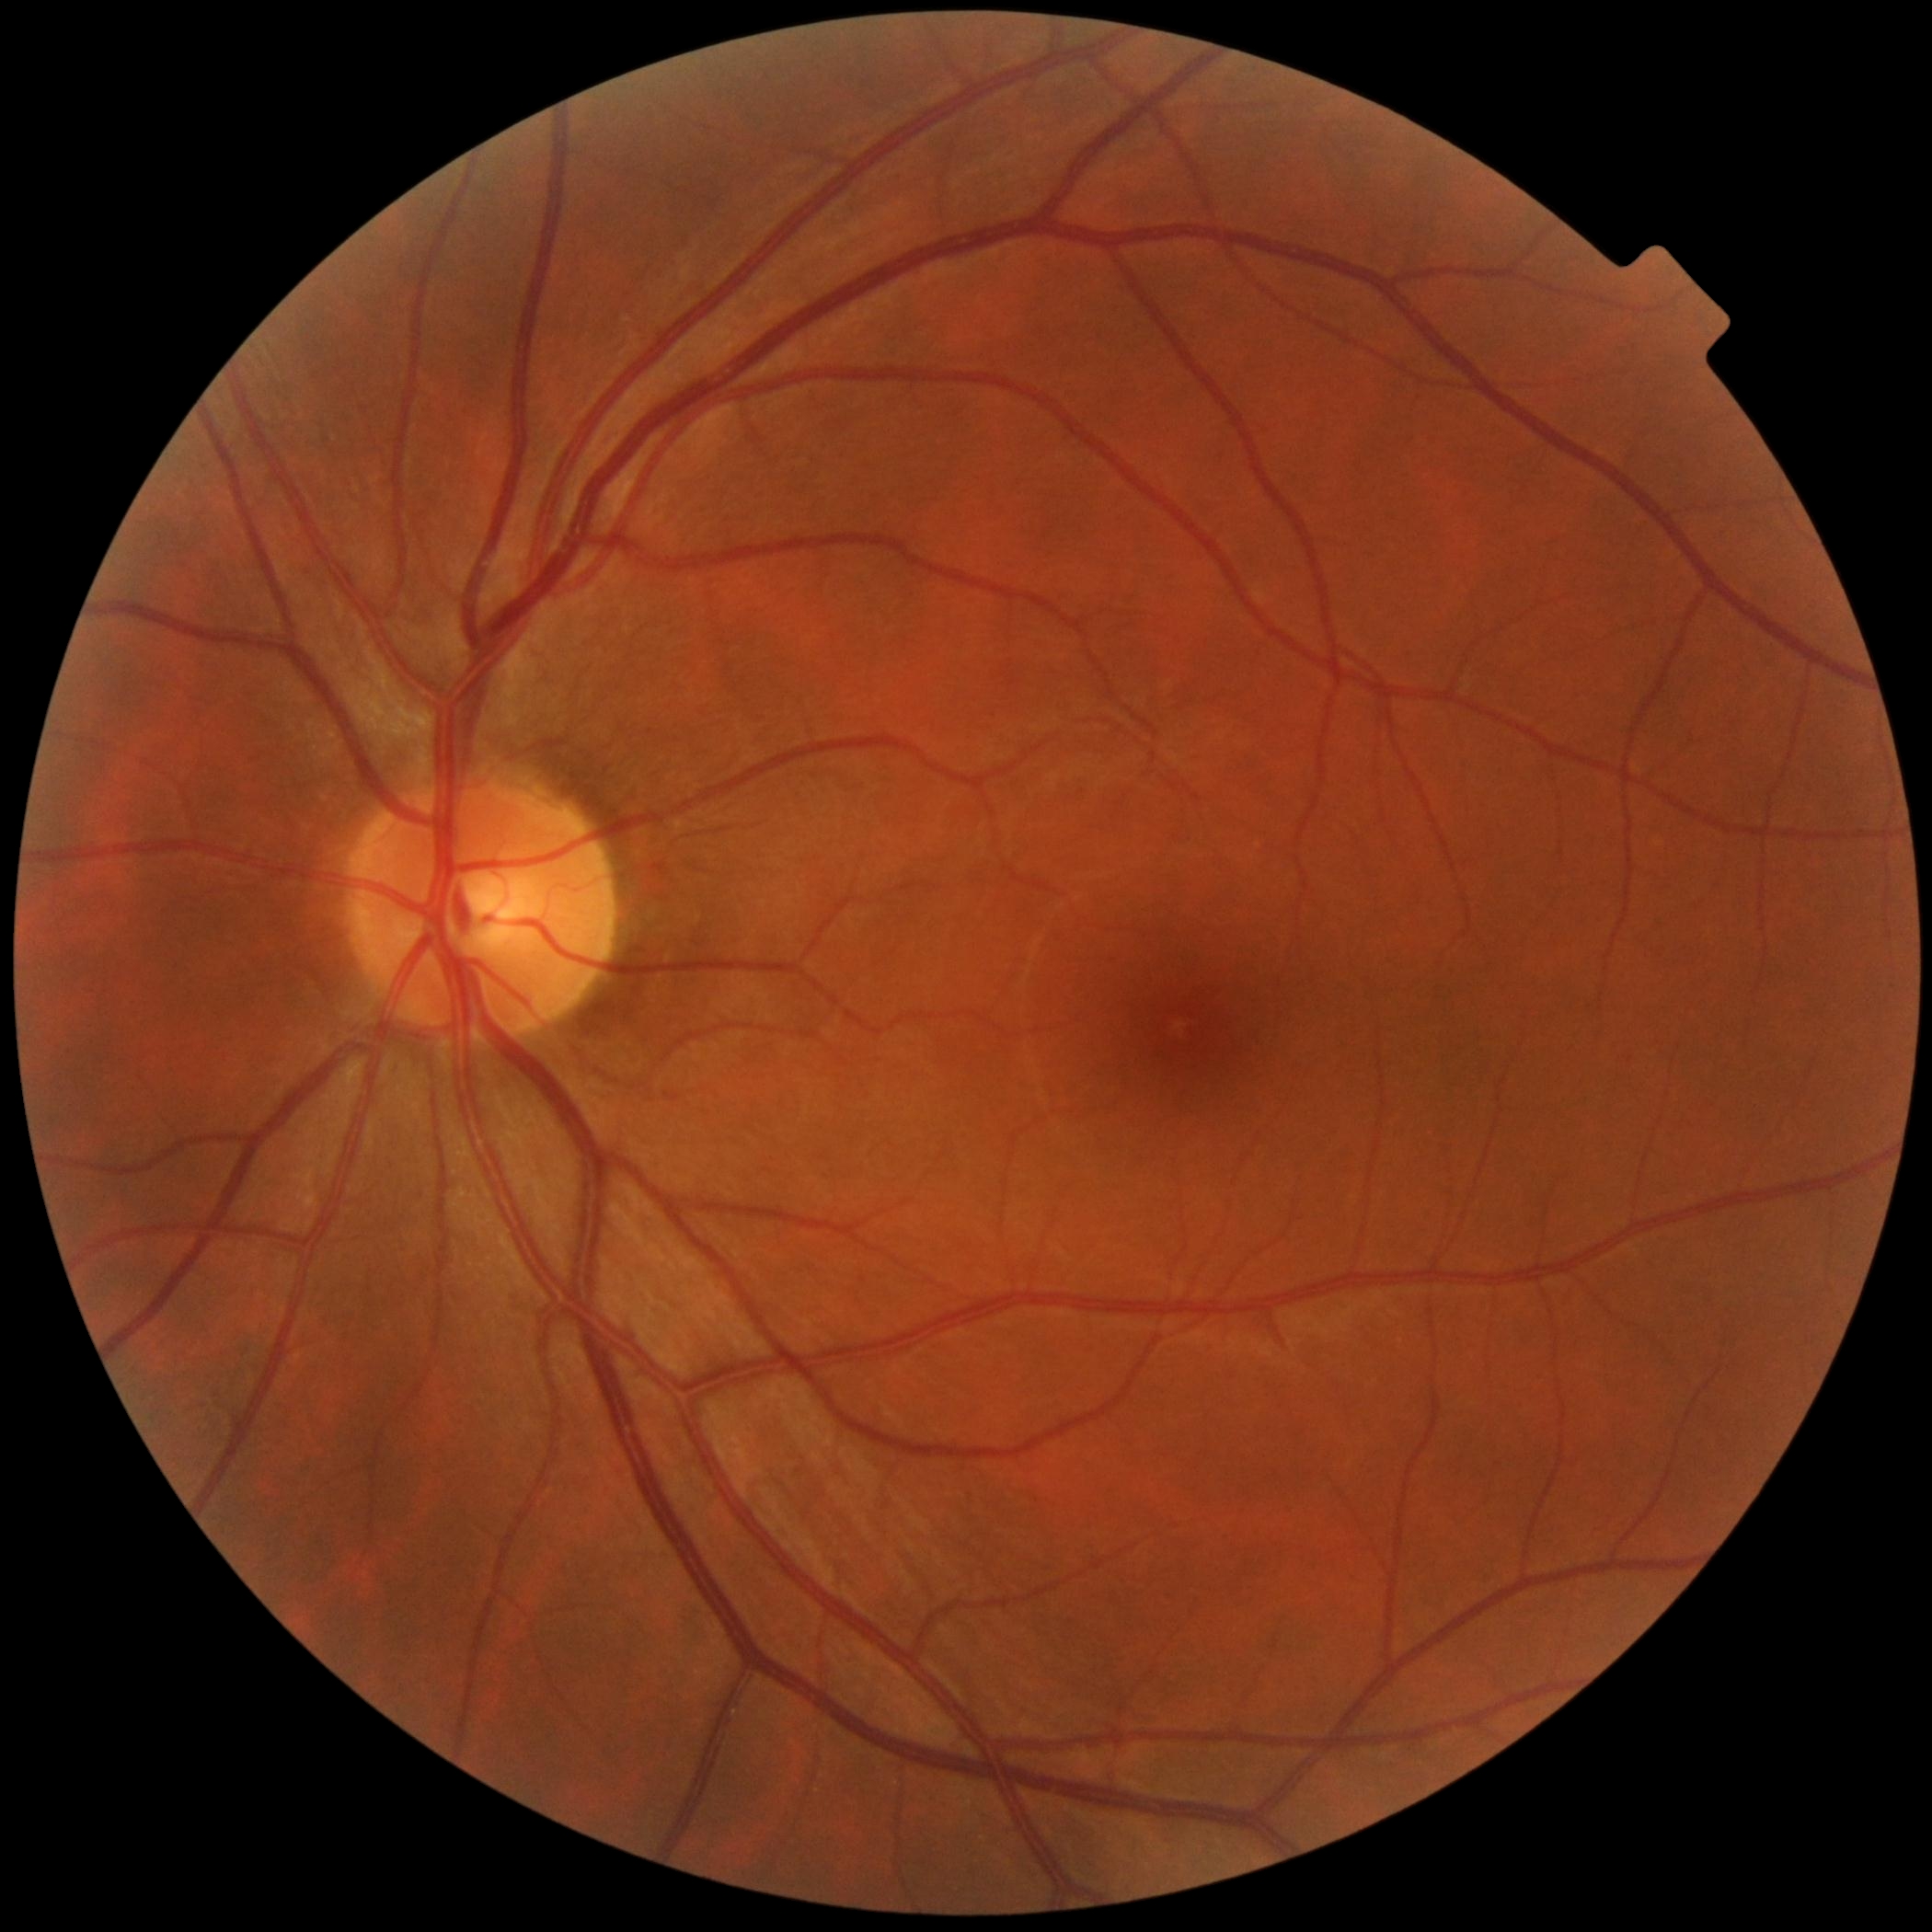 No apparent diabetic retinopathy. DR stage is no apparent retinopathy (grade 0).